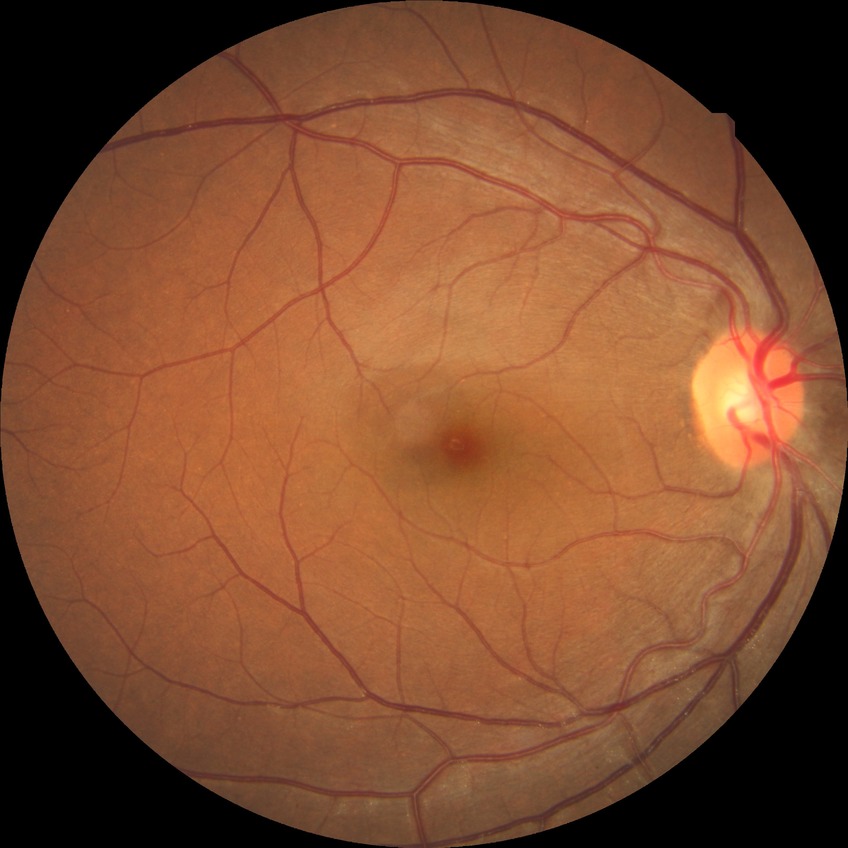
Davis stage is NDR.